Infant wide-field retinal image
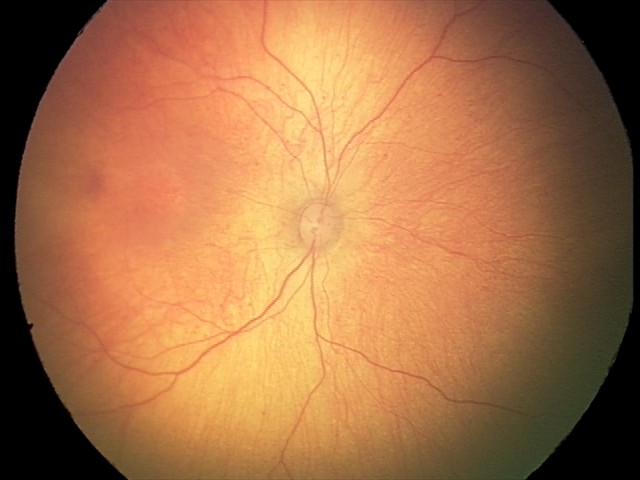 Screening examination with no abnormal retinal findings.